2352 by 1568 pixels. 45° field of view.
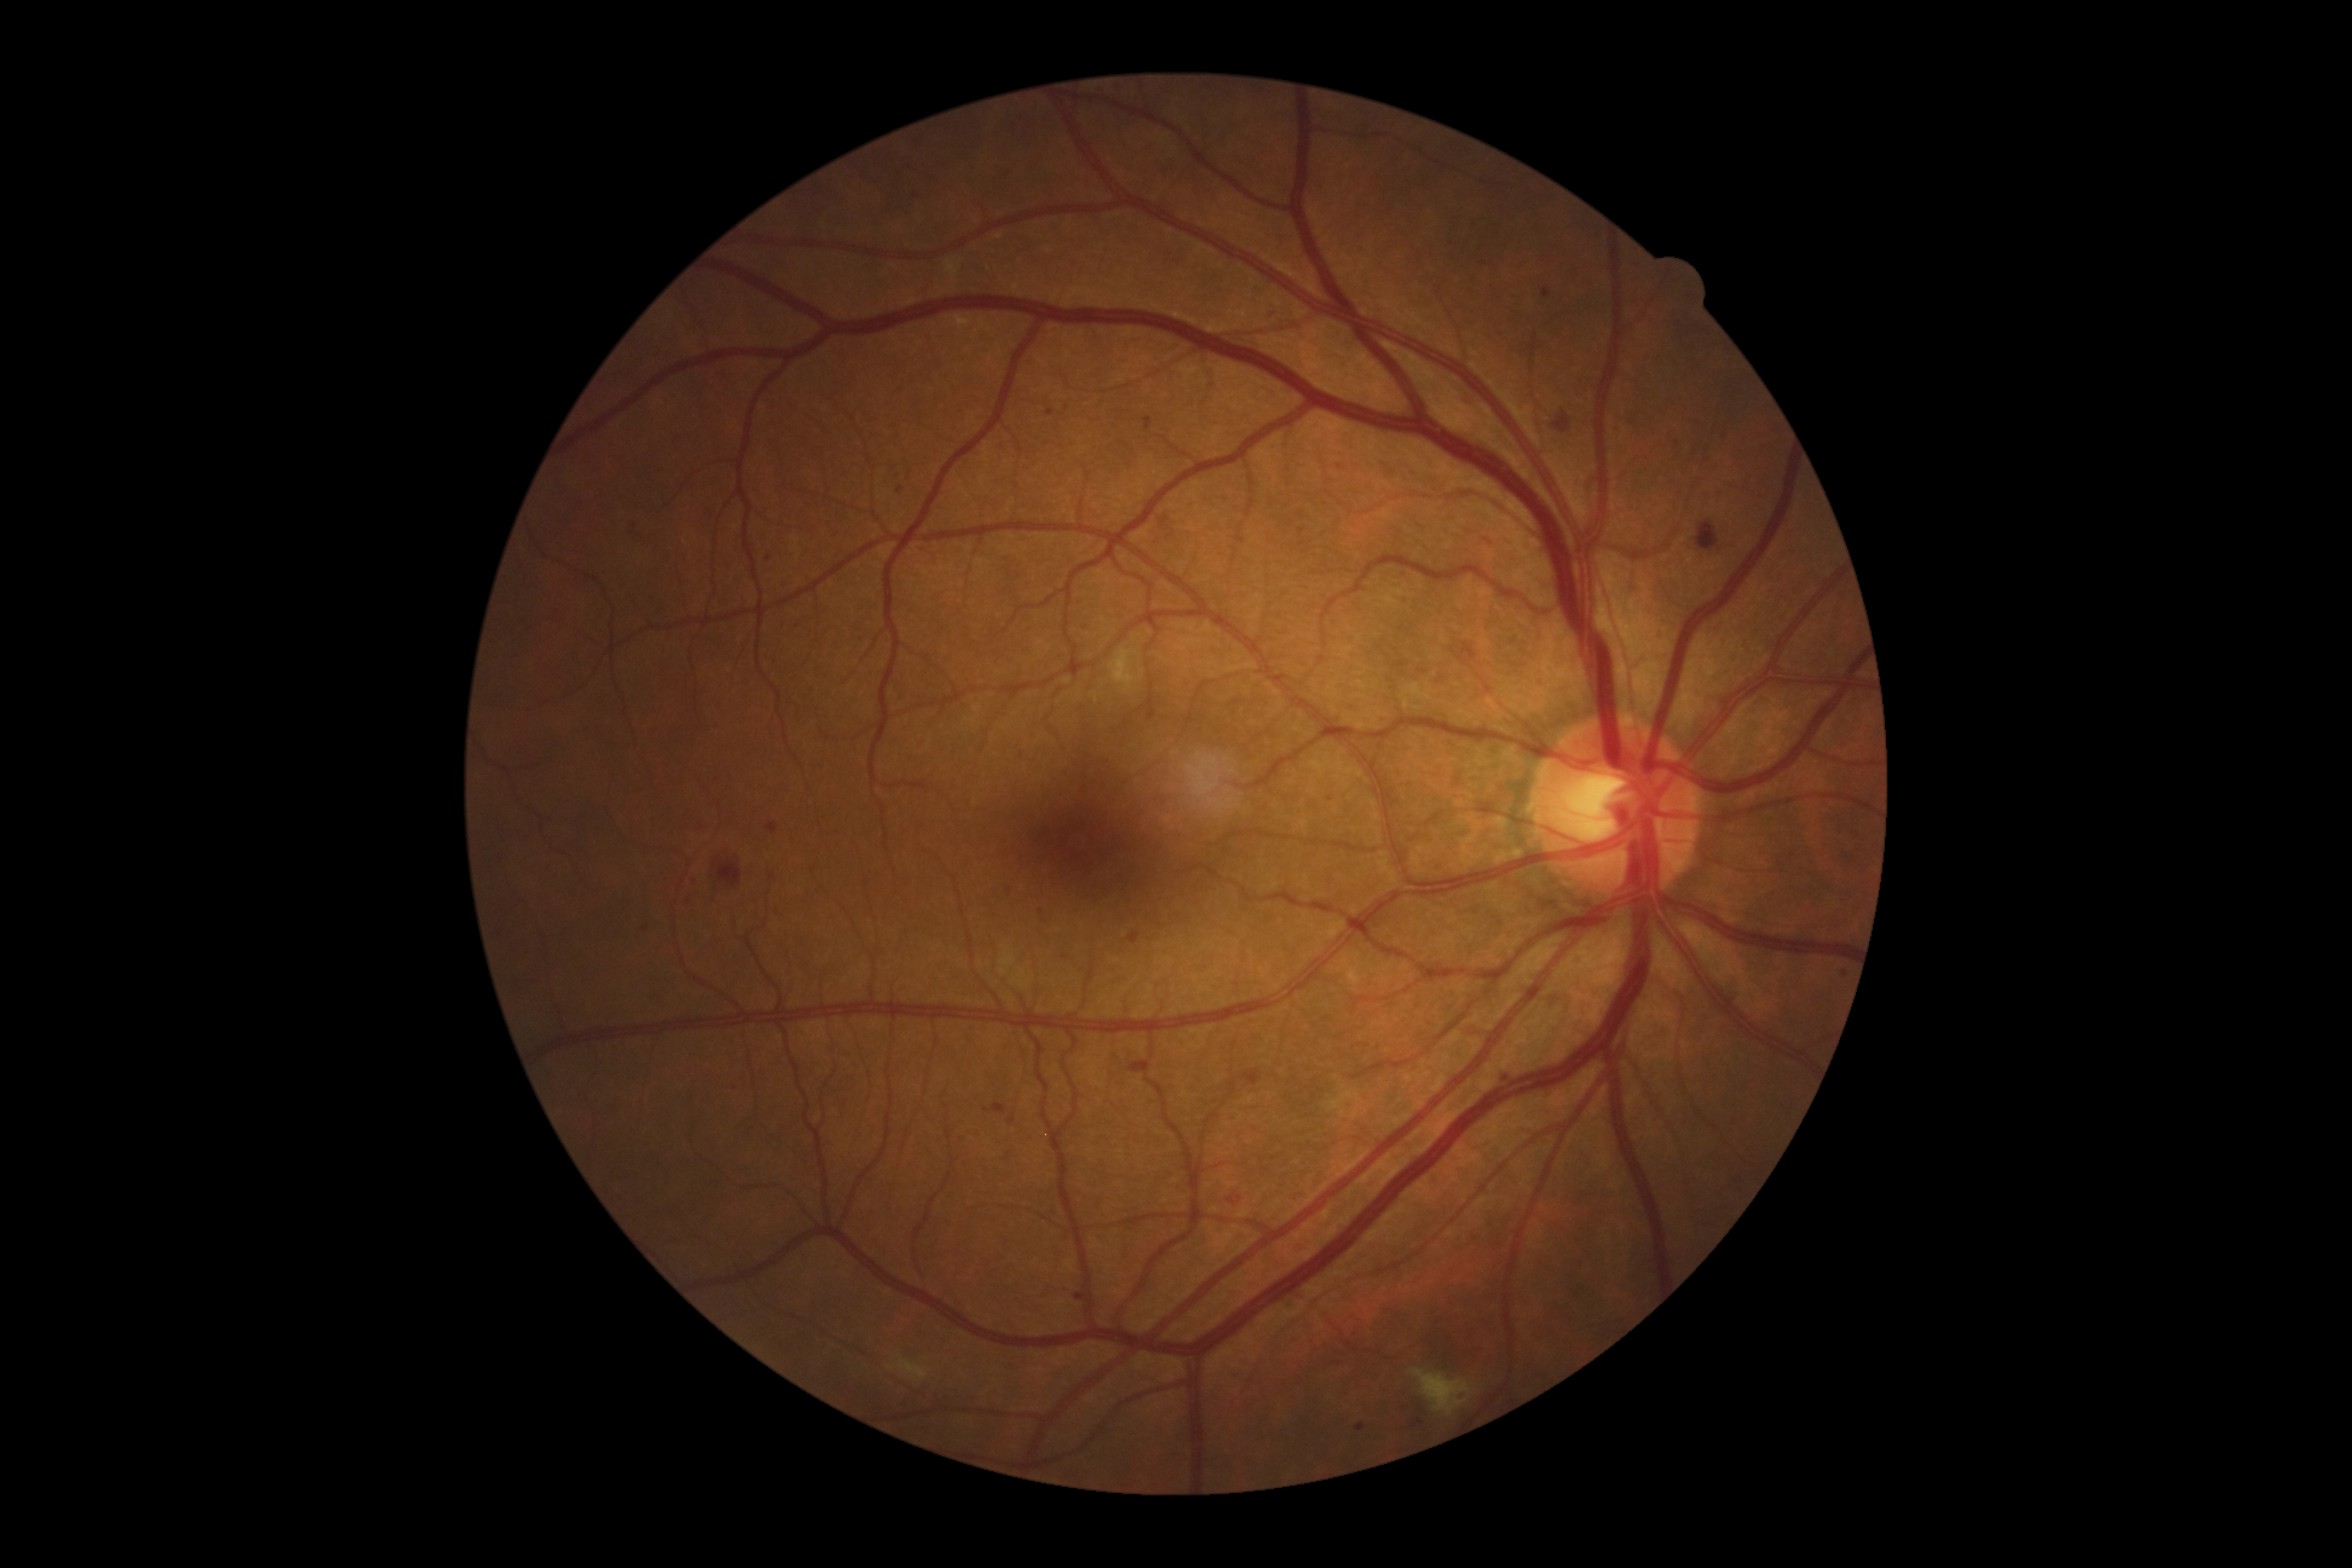

Retinopathy grade is moderate NPDR (2)
A subset of detected lesions:
soft exudates: (left=1109, top=647, right=1139, bottom=689); (left=886, top=1356, right=929, bottom=1383); (left=1410, top=1369, right=1473, bottom=1416)
hard exudates: absent
hemorrhages: (left=1383, top=464, right=1397, bottom=479); (left=1128, top=932, right=1142, bottom=944); (left=713, top=857, right=742, bottom=886); (left=1129, top=1062, right=1151, bottom=1075); (left=1241, top=1070, right=1260, bottom=1086); (left=1227, top=1194, right=1243, bottom=1206); (left=1697, top=522, right=1720, bottom=551); (left=1553, top=411, right=1571, bottom=434)
Small hemorrhages near 1488:542
microaneurysms (partial): (left=774, top=581, right=786, bottom=589); (left=1269, top=312, right=1277, bottom=316); (left=1144, top=418, right=1152, bottom=431); (left=1612, top=426, right=1621, bottom=433); (left=993, top=1104, right=1007, bottom=1115); (left=1077, top=1292, right=1086, bottom=1299); (left=1021, top=752, right=1024, bottom=760); (left=1005, top=884, right=1013, bottom=891); (left=1356, top=1423, right=1365, bottom=1432)
Small microaneurysms near 768:559; 1085:628; 1845:974; 823:766; 899:388; 646:928; 962:1136; 1330:800